Retinal fundus photograph; 2184x1690px; 45° FOV:
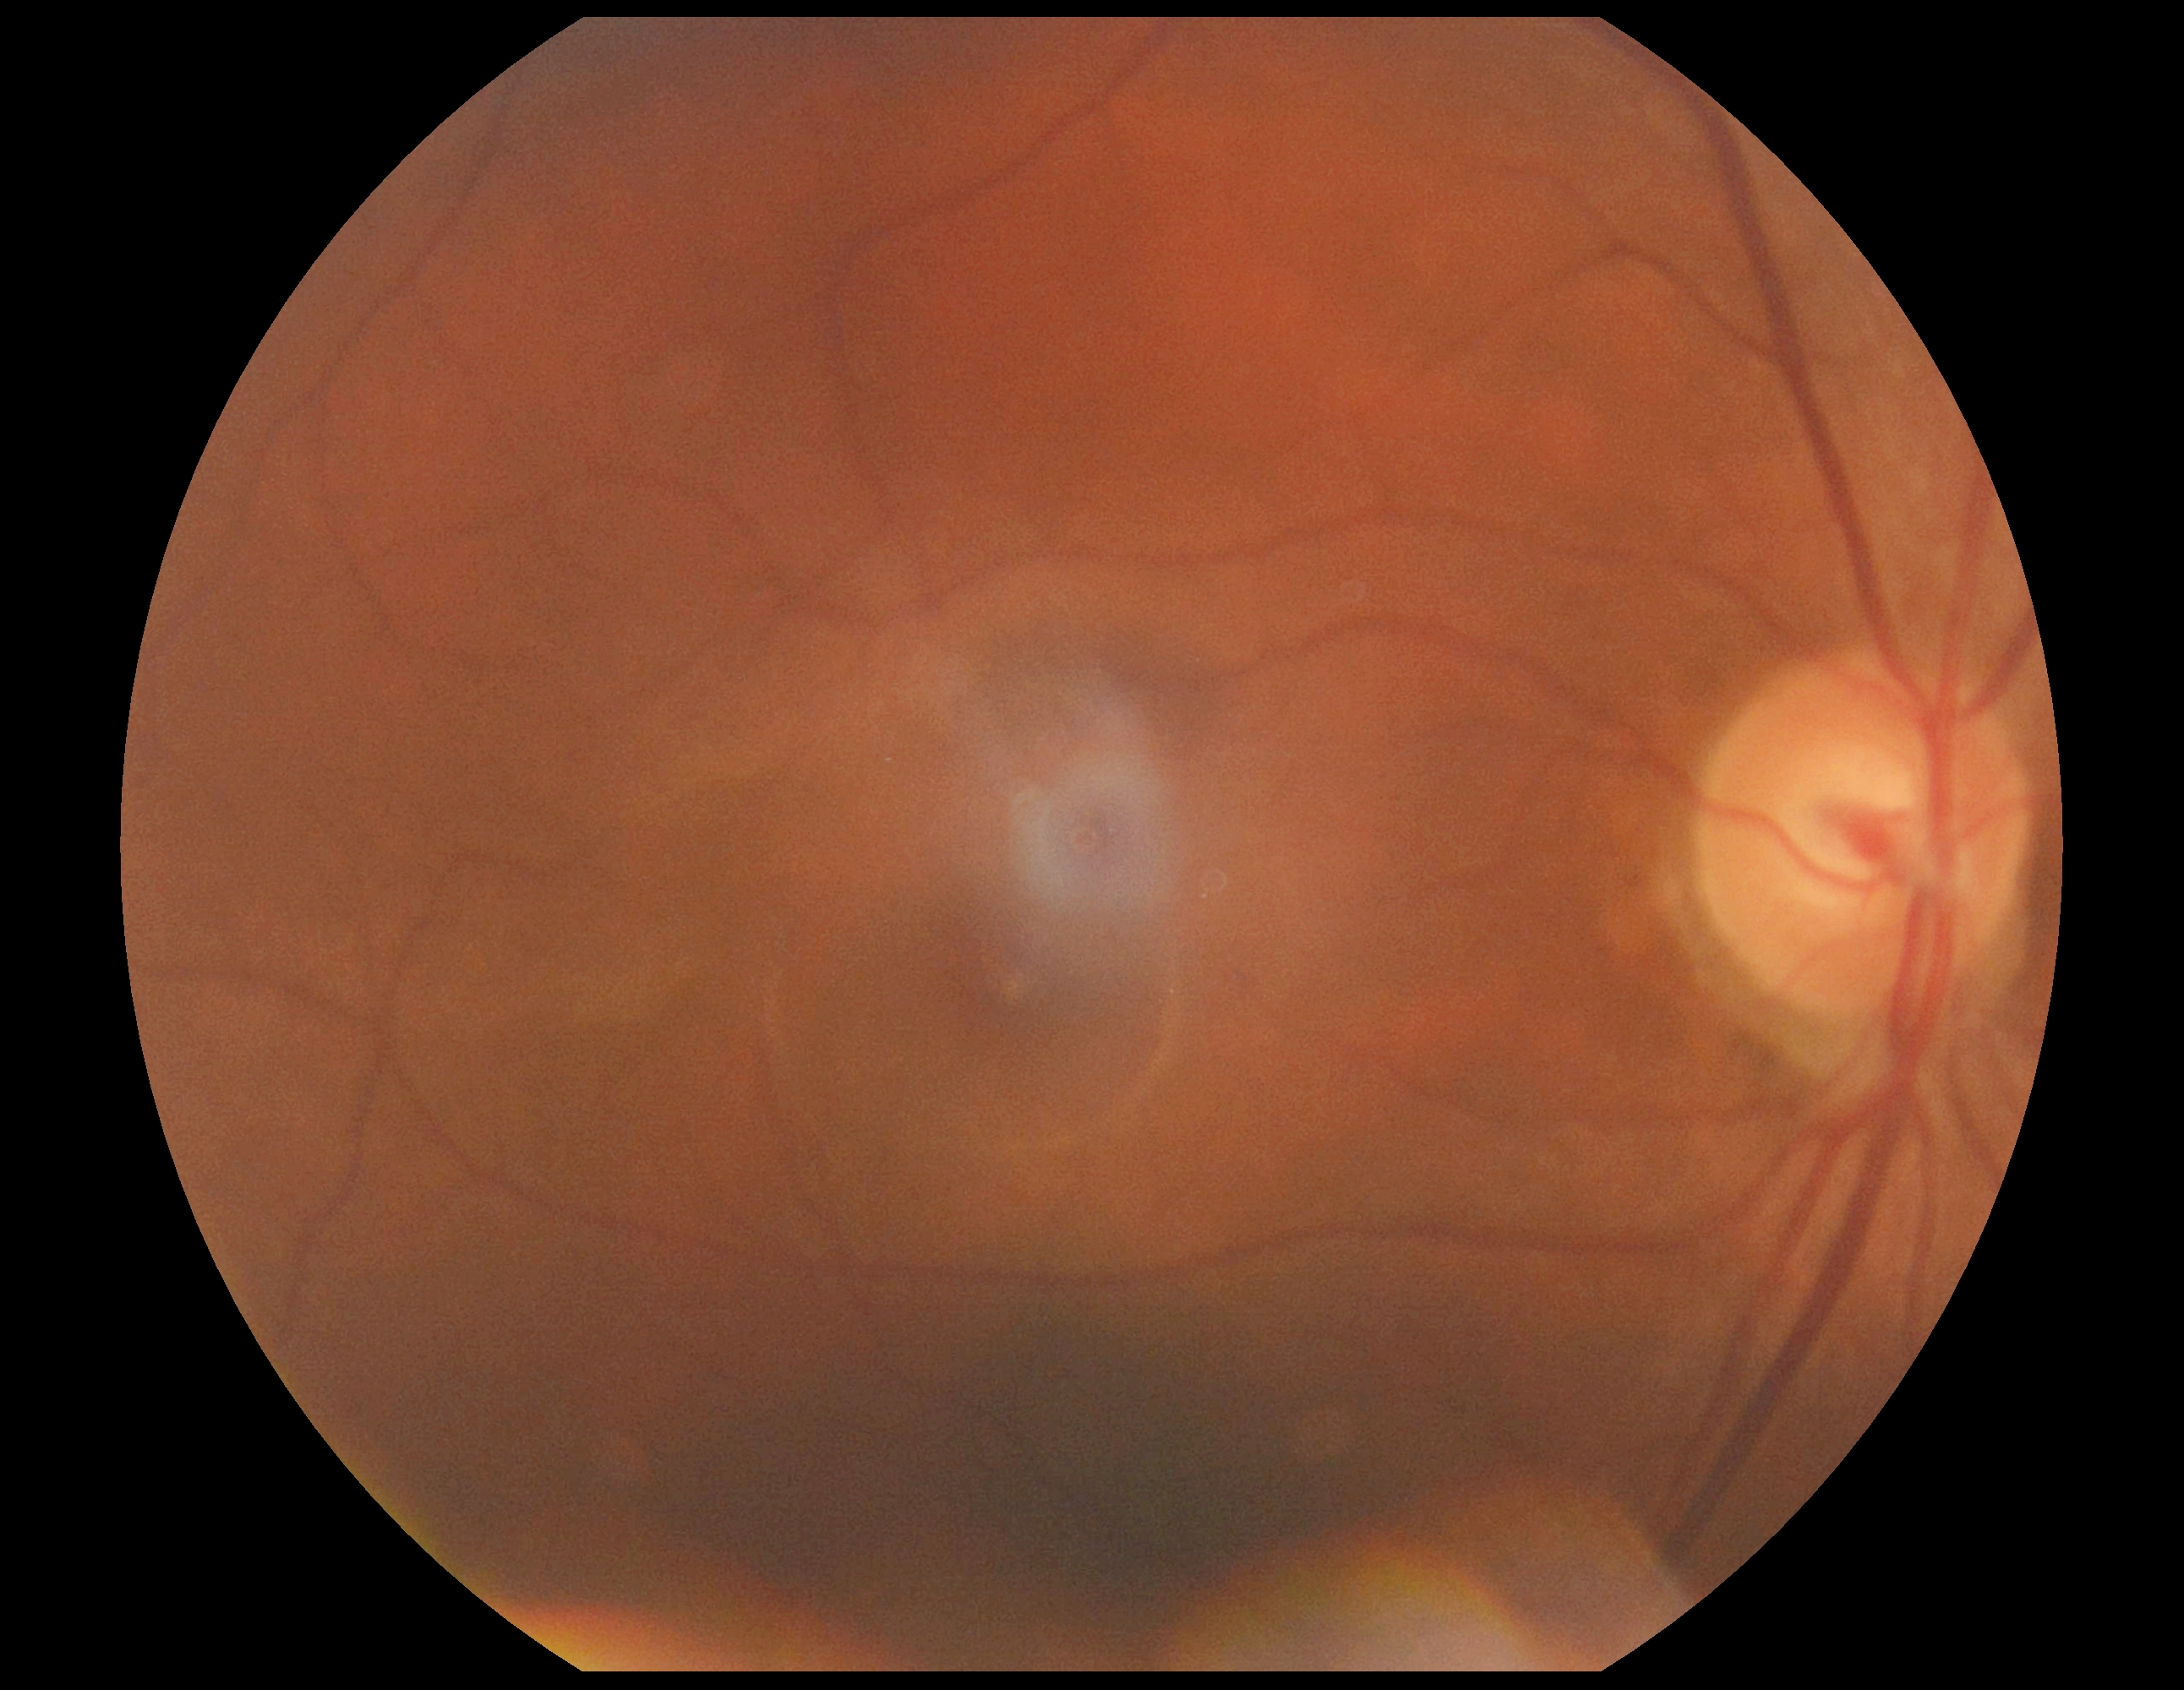 retinopathy grade: 0 | DR impression: no signs of DR.